Wide-field retinal mosaic image:
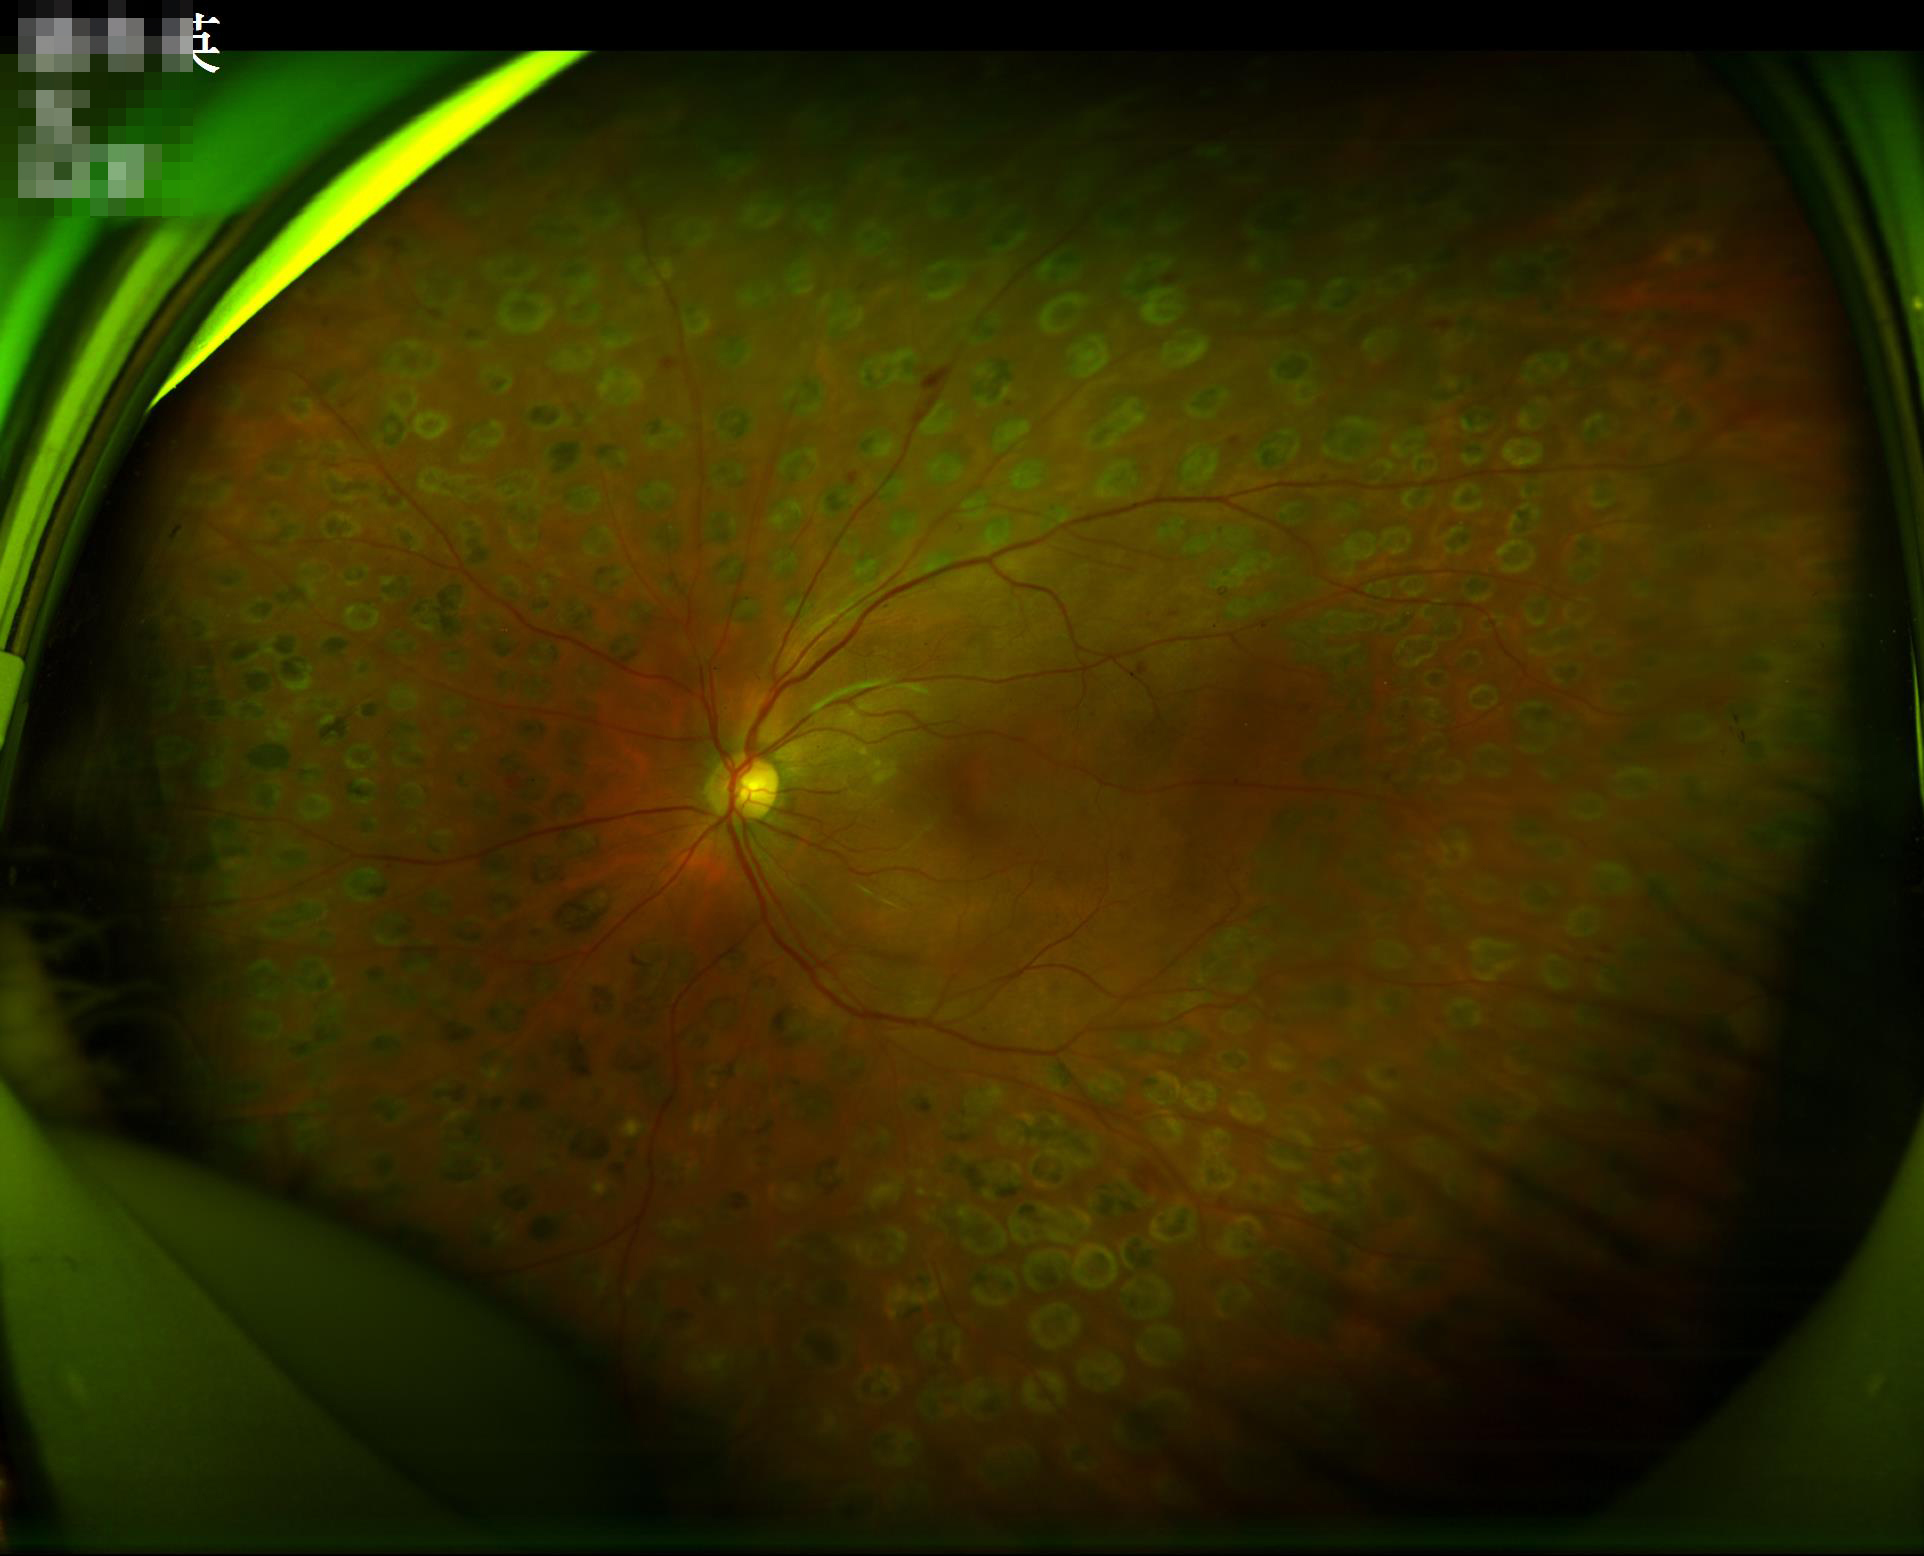 Clarity = good; Illumination = poor; Overall image quality = acceptable.